Image size 2048x1536, fundus photo, FOV: 45 degrees
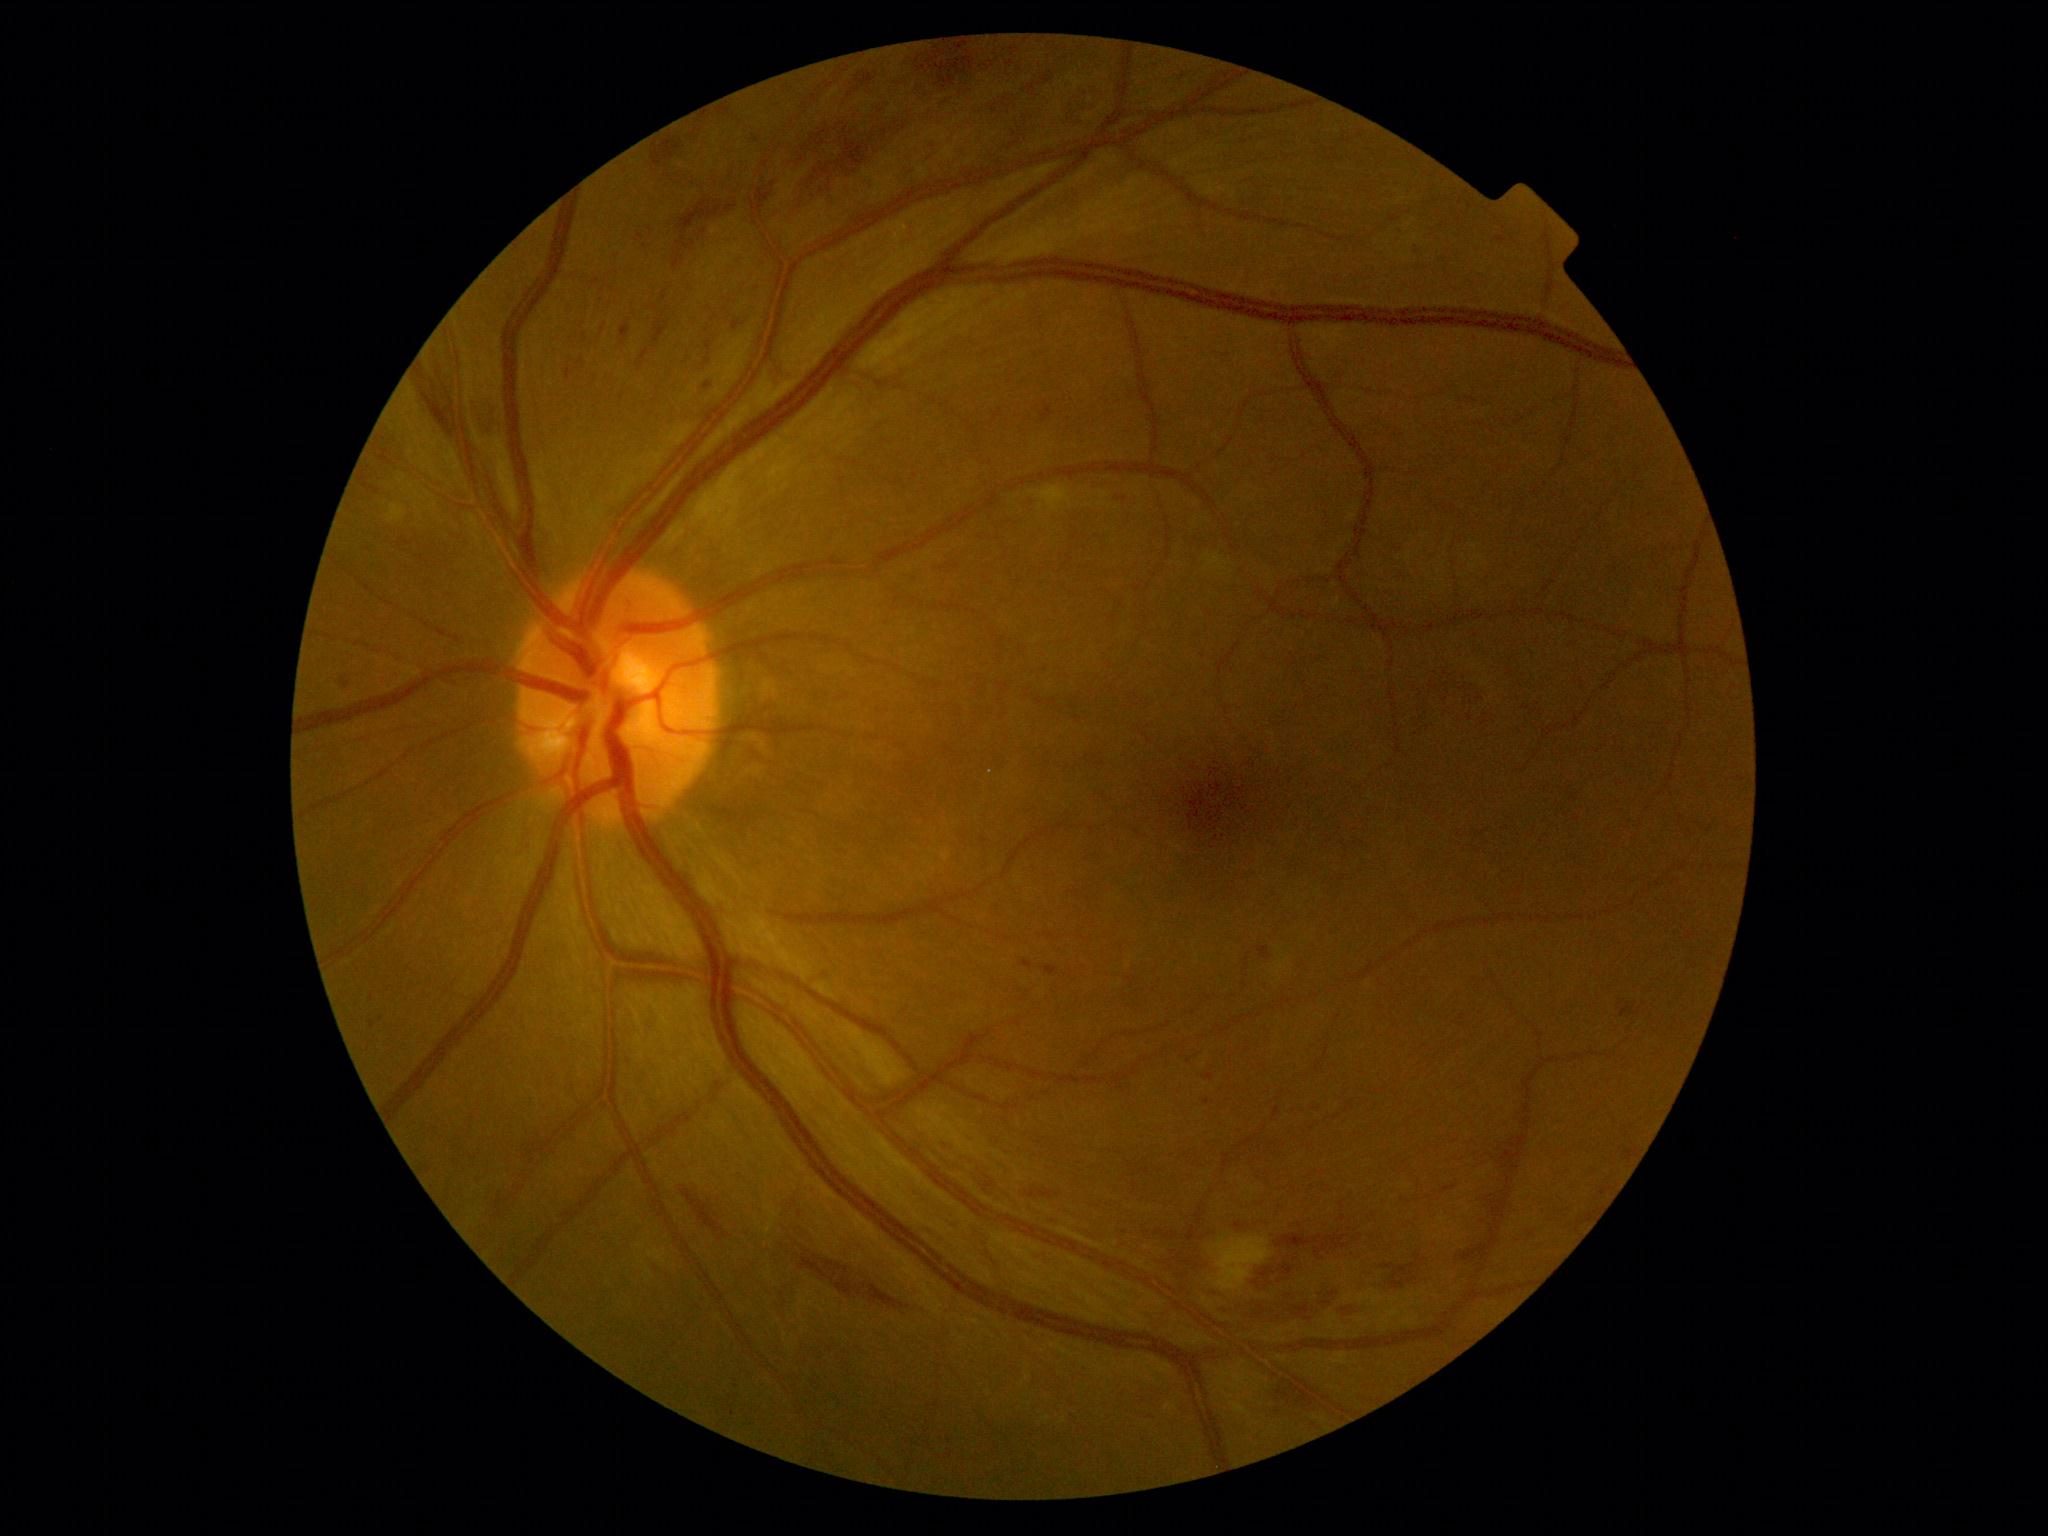 Diabetic retinopathy (DR) is grade 2 (moderate NPDR).